Tabletop color fundus camera image — 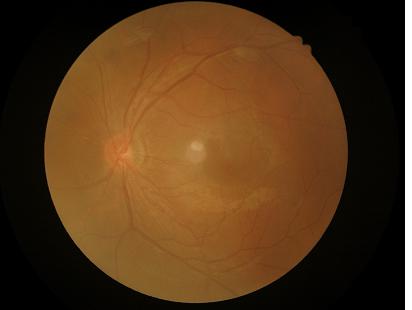 Narrow intensity range; structures are hard to distinguish. Image is sharp throughout the field. No over- or under-exposure. Image quality is inadequate for diagnostic use.